Wide-field fundus photograph of an infant — 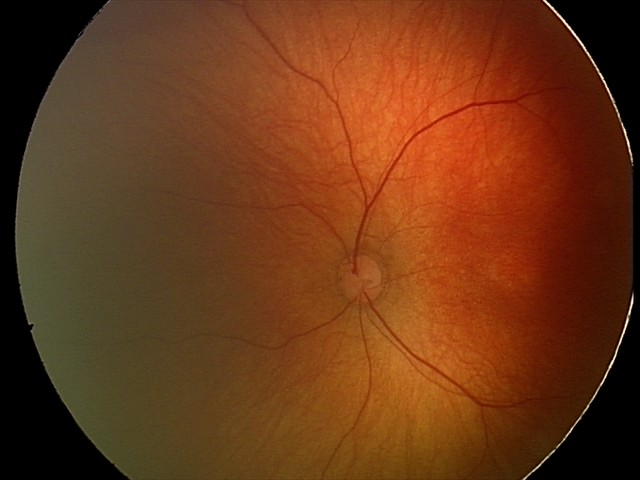

Screening: no abnormal retinal findings.